45° field of view, color fundus photograph, 1932 x 1916 pixels: 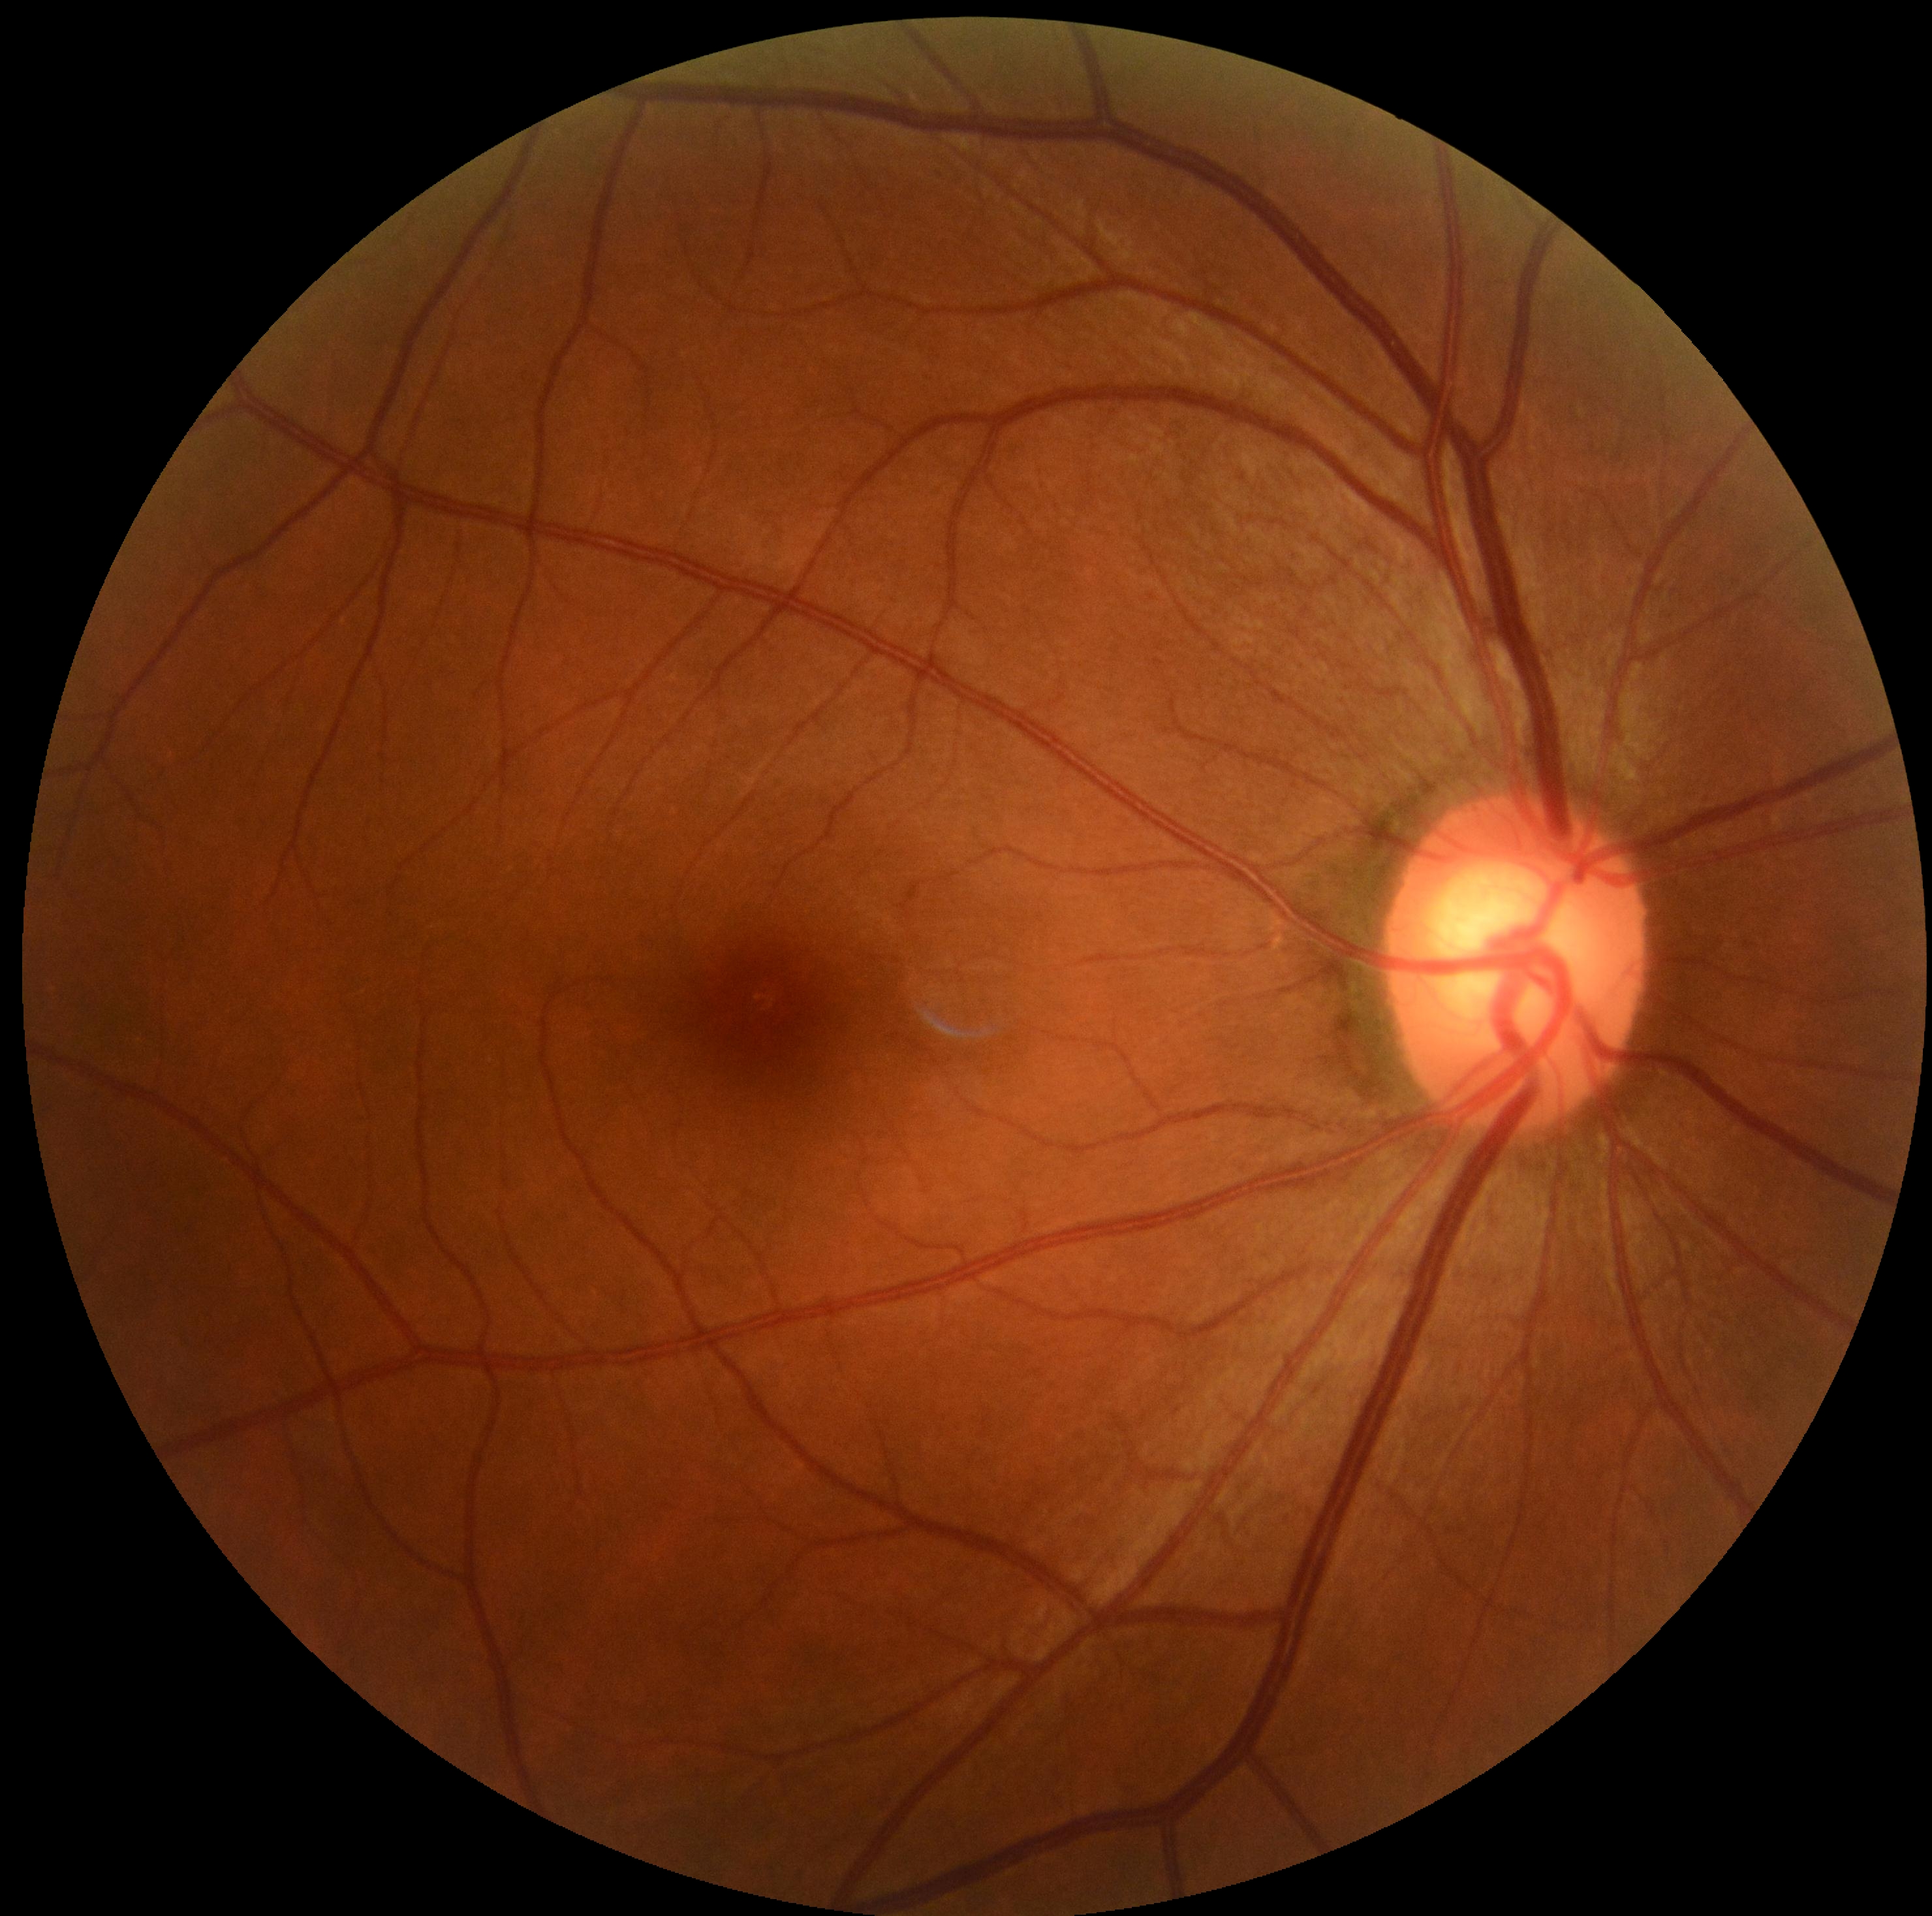
{
  "dr_grade": "0/4"
}